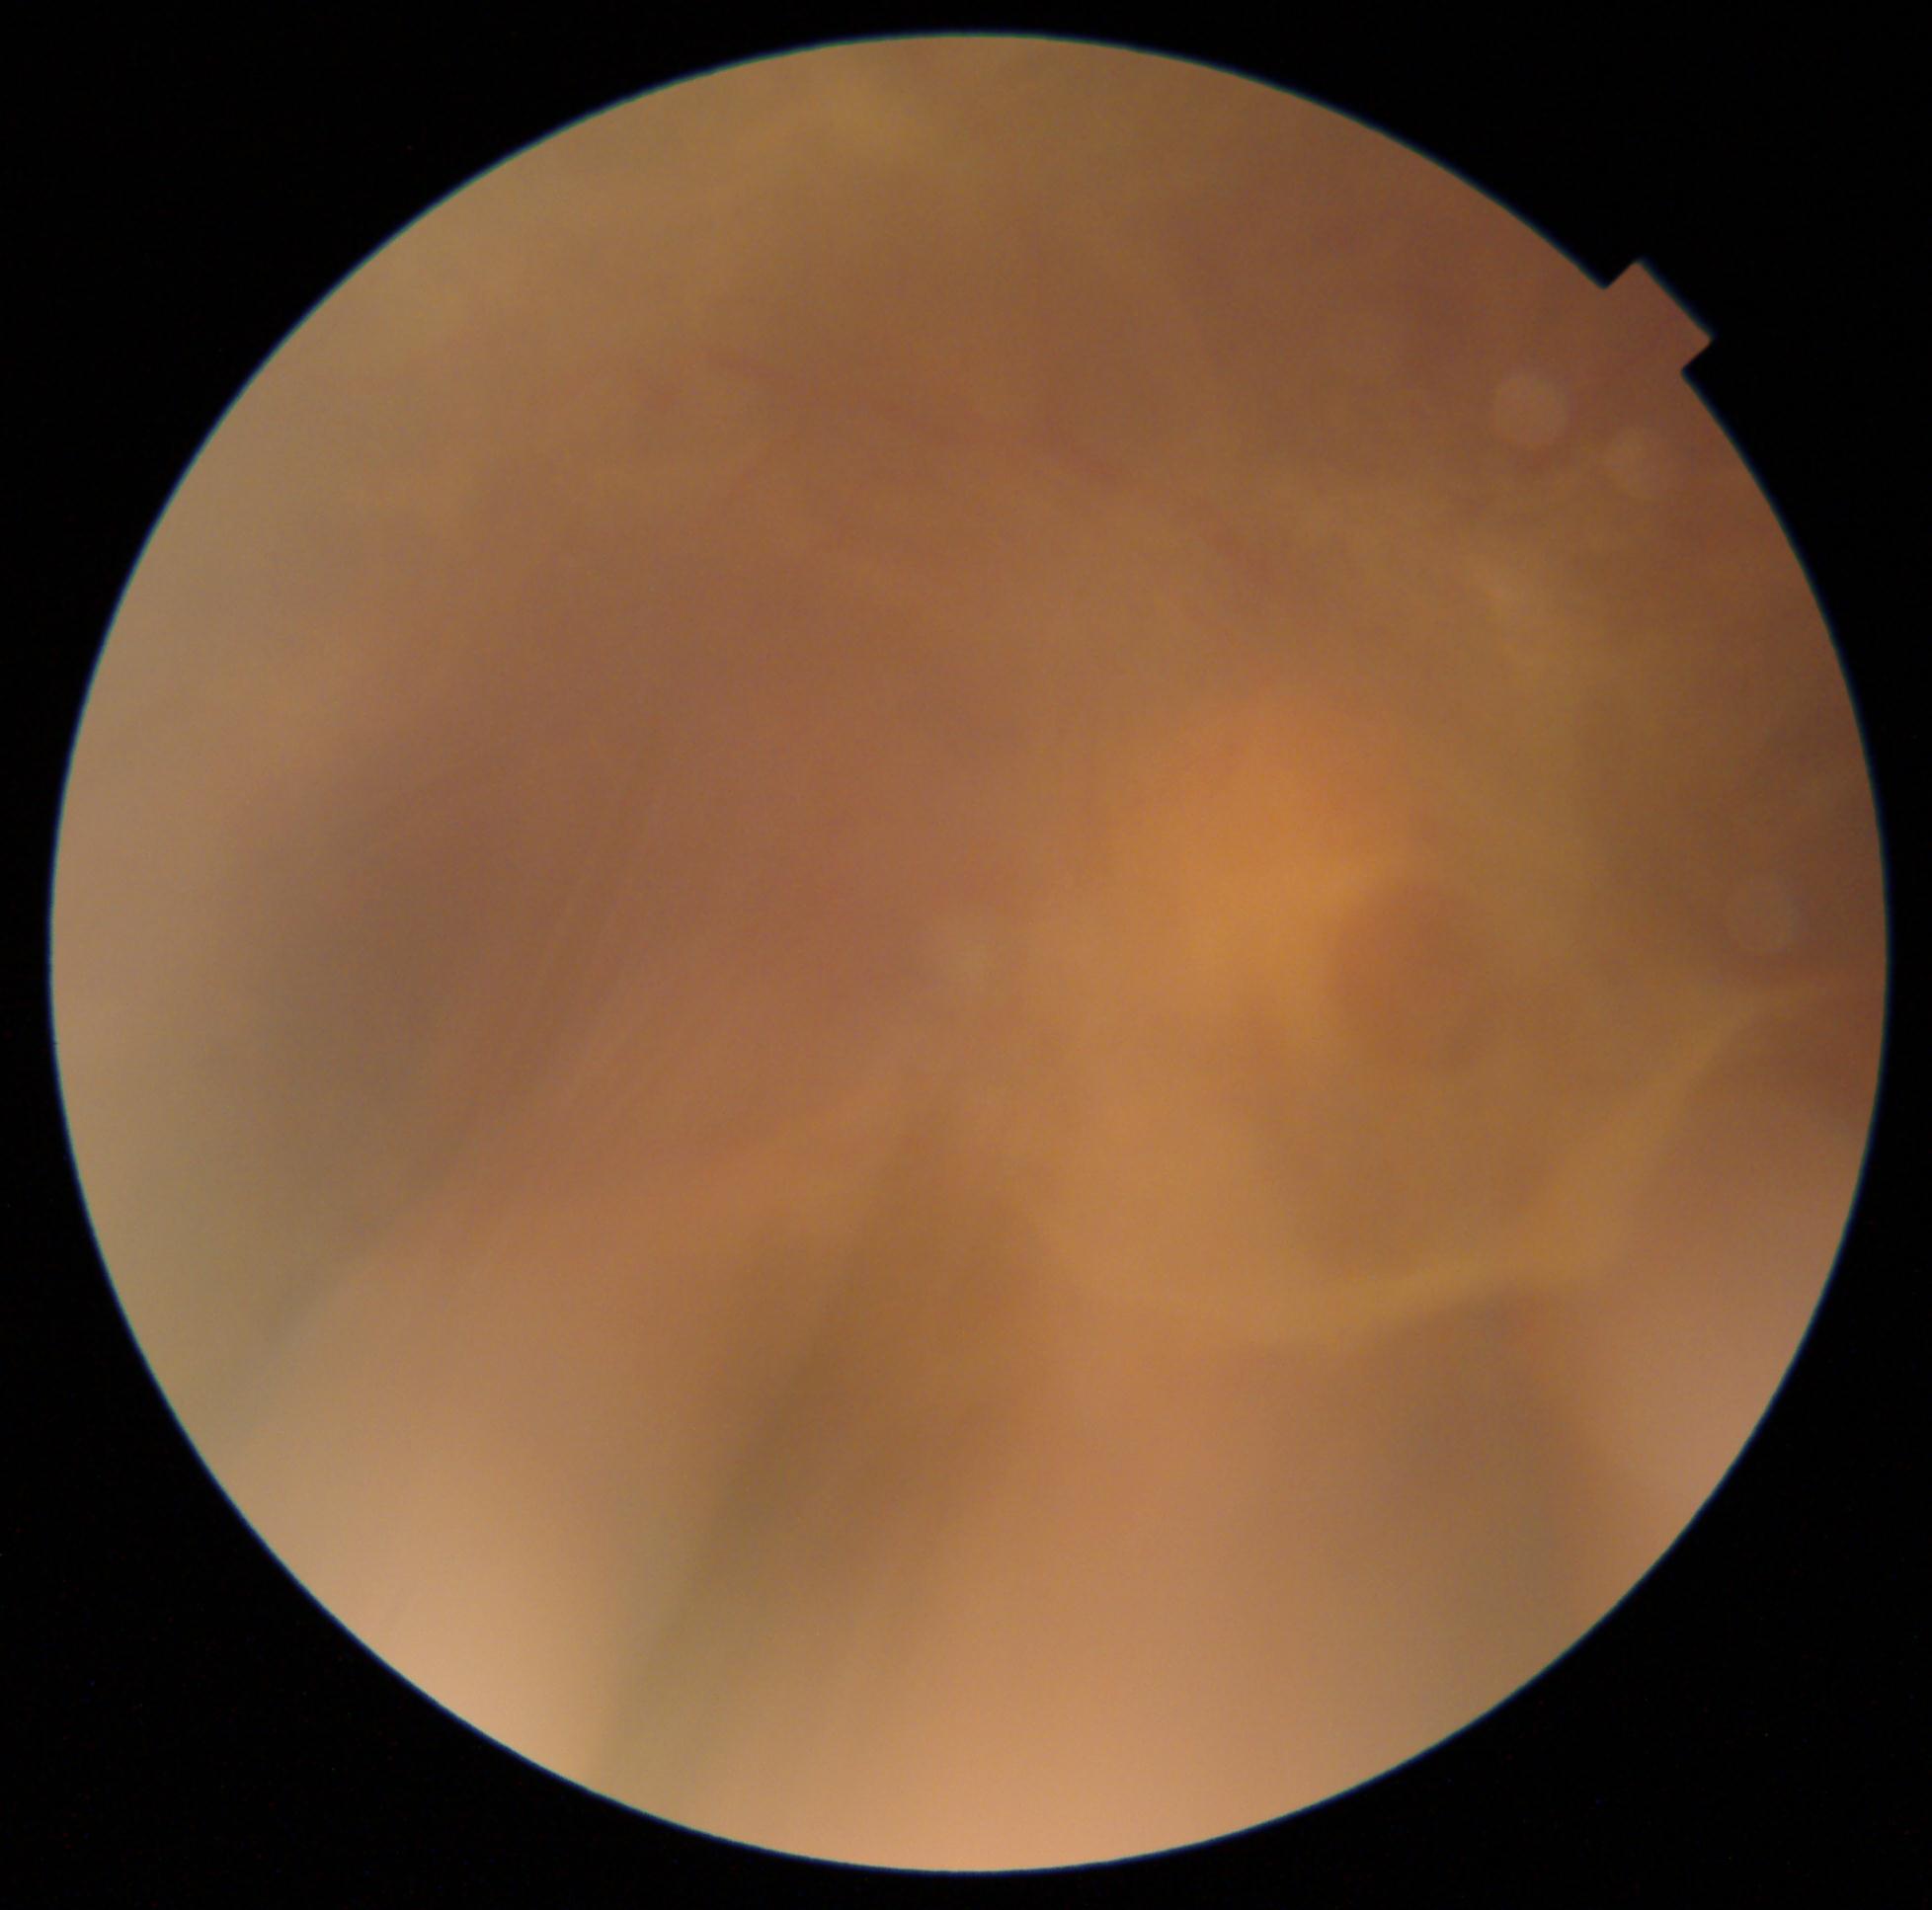
DR grade is PDR (4).